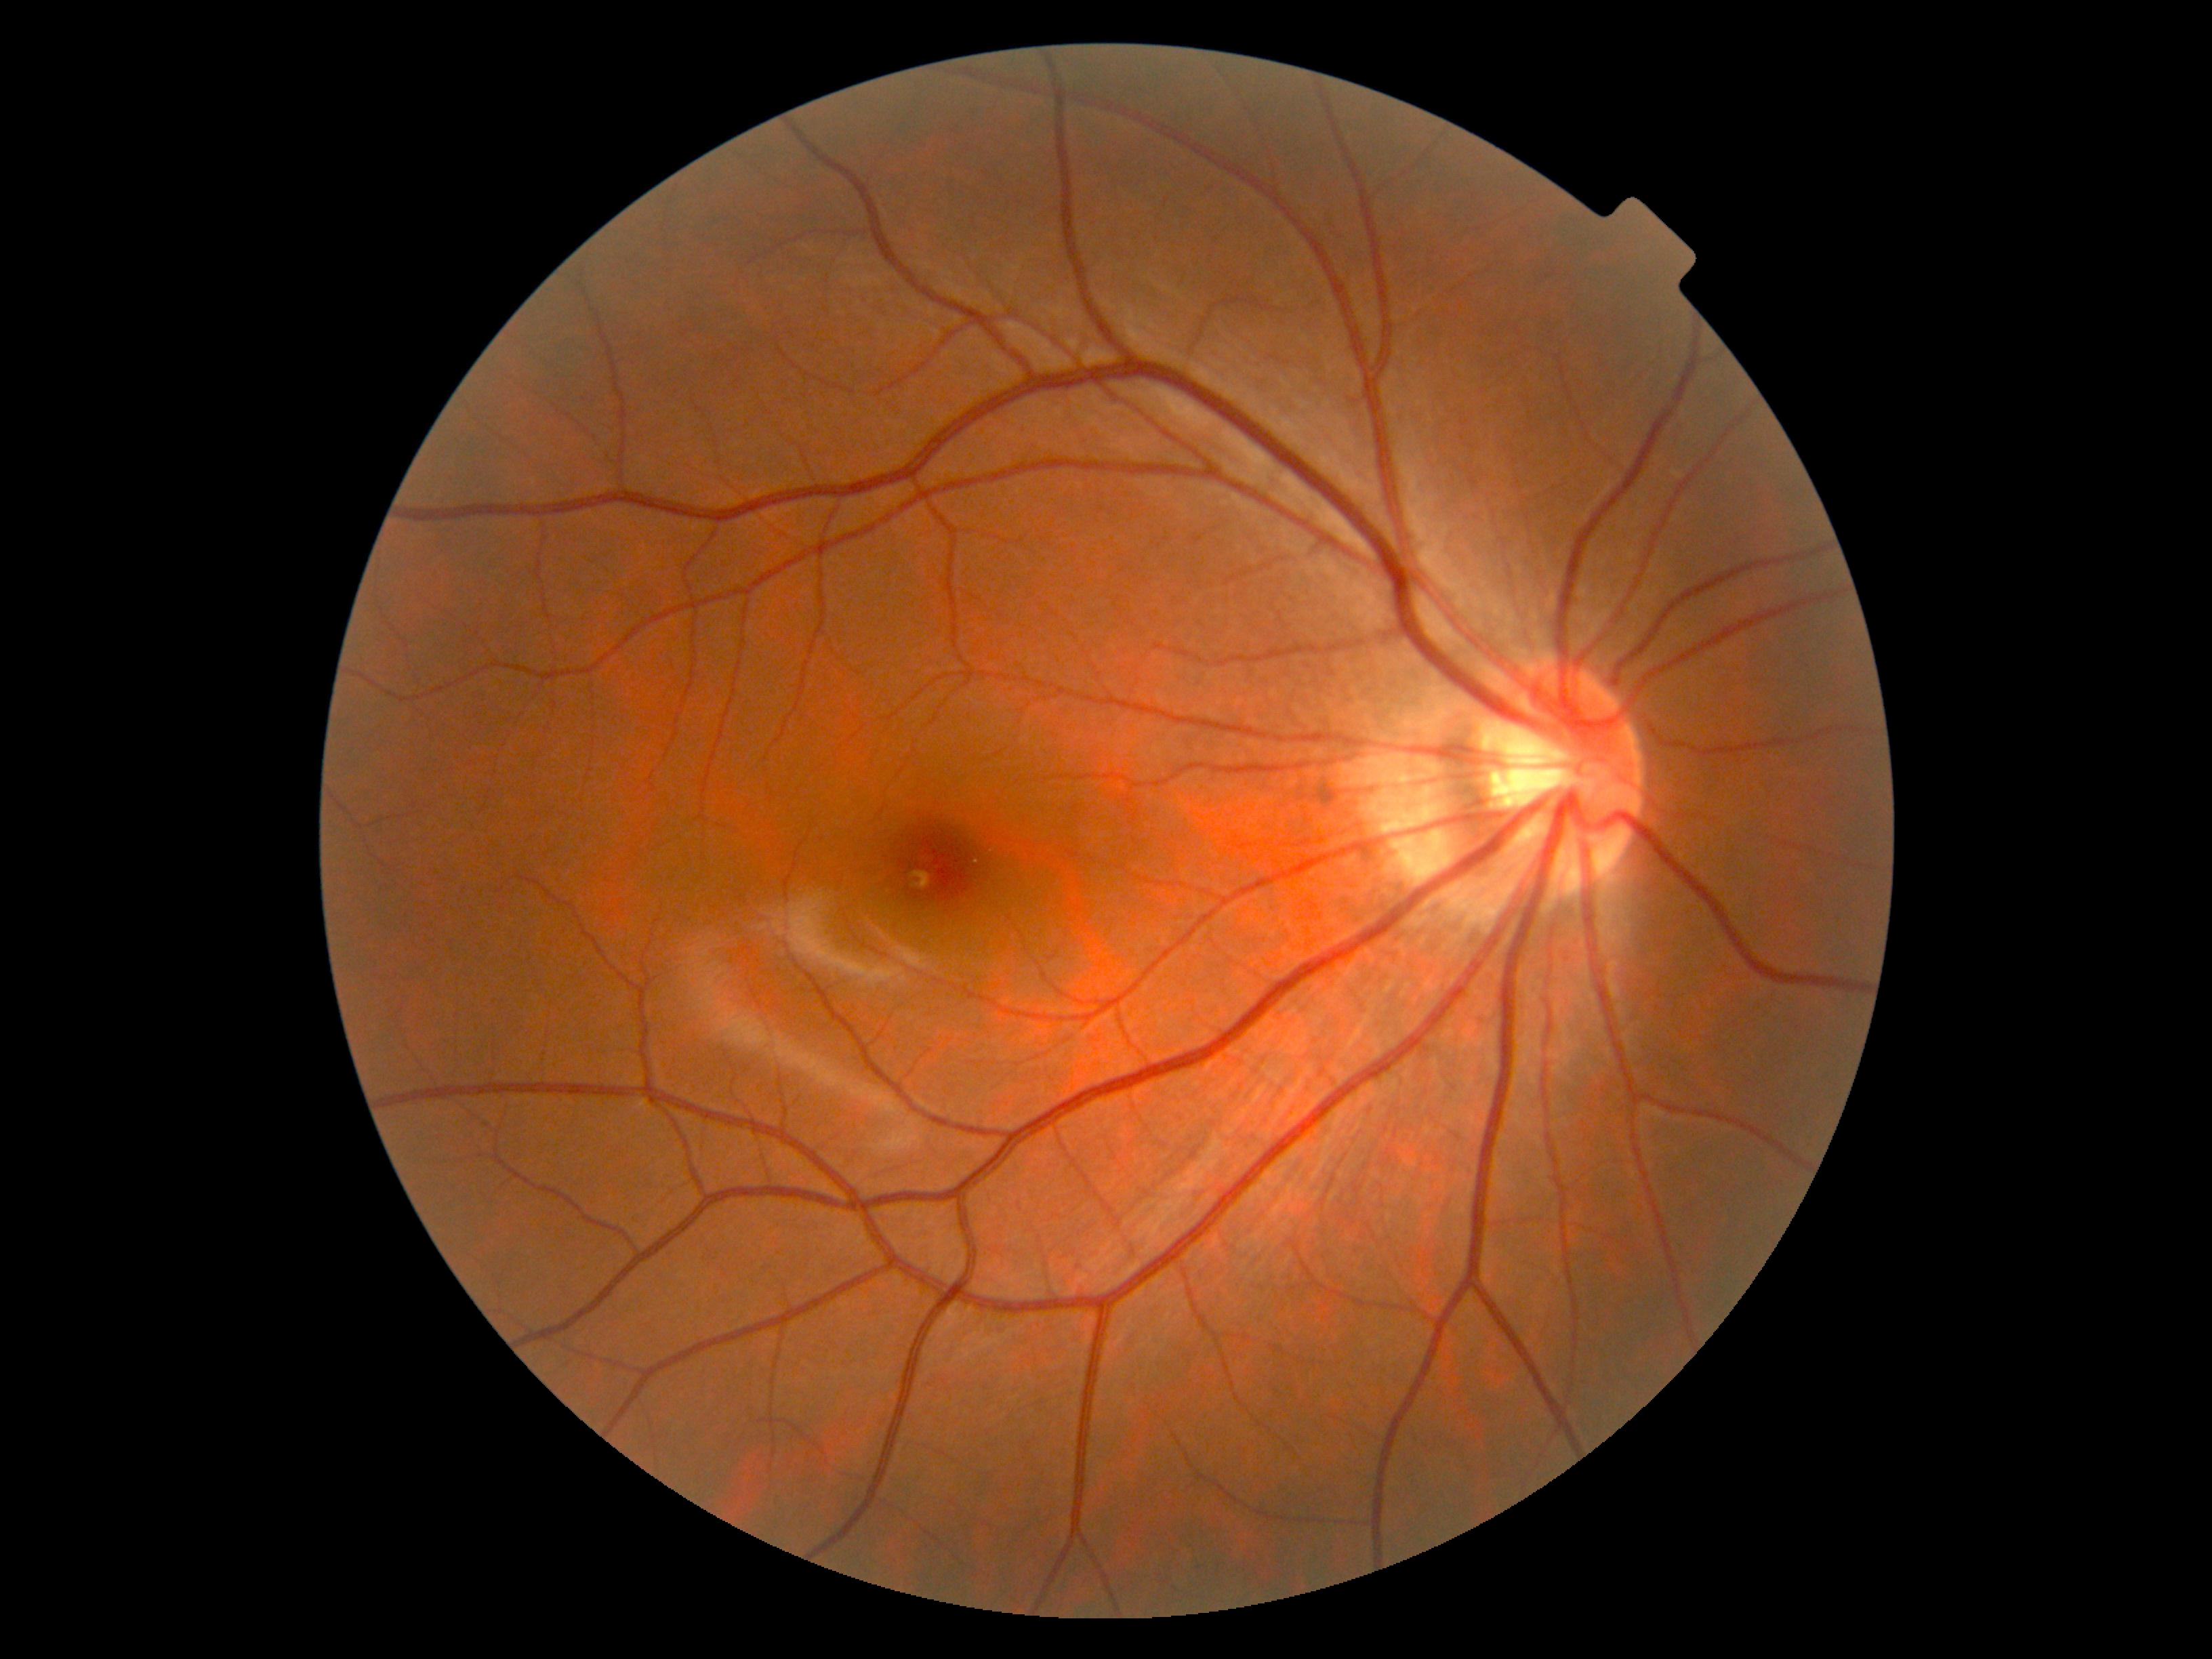

DR impression=no signs of DR, diabetic retinopathy (DR)=0/4.